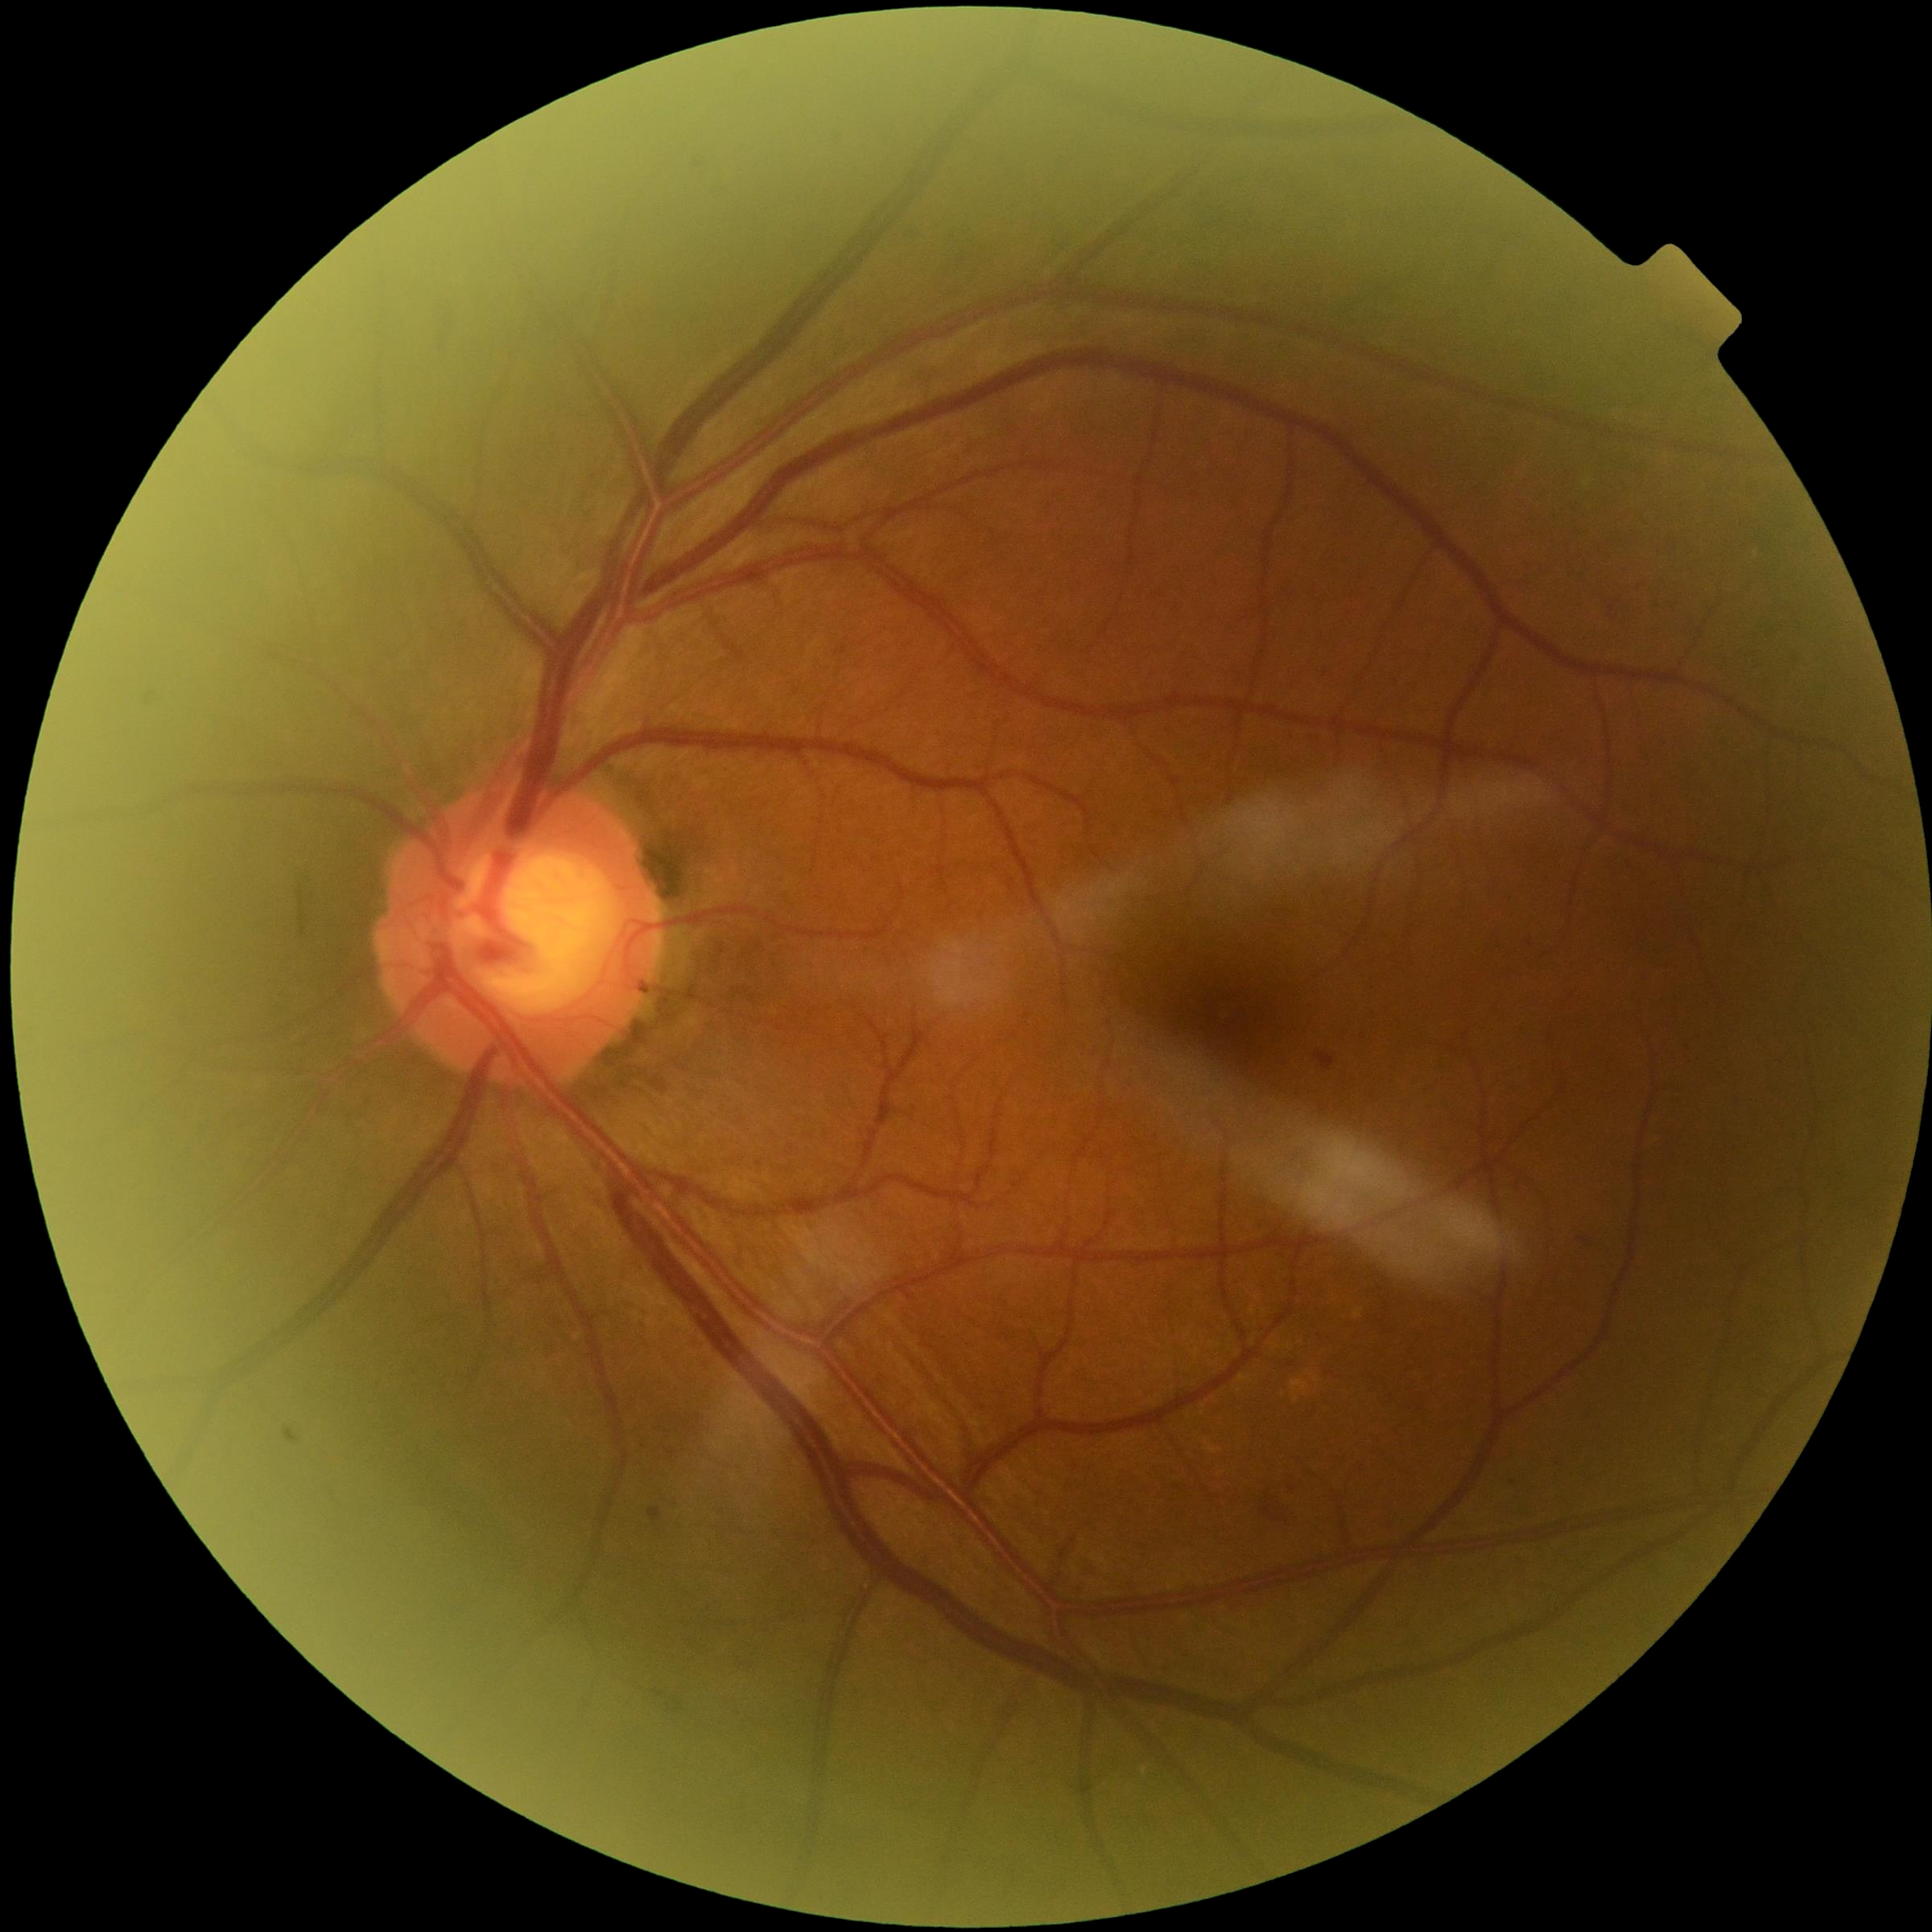

DR class = non-proliferative diabetic retinopathy; DR stage = moderate non-proliferative diabetic retinopathy (grade 2).